Captured with the Clarity RetCam 3 (130° field of view) · infant wide-field fundus photograph:
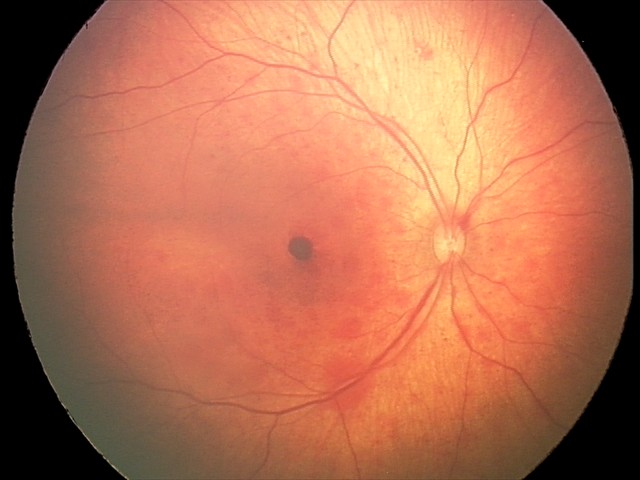

Q: What is the screening diagnosis?
A: retinal hemorrhages